Modified Davis grading, camera: NIDEK AFC-230 — 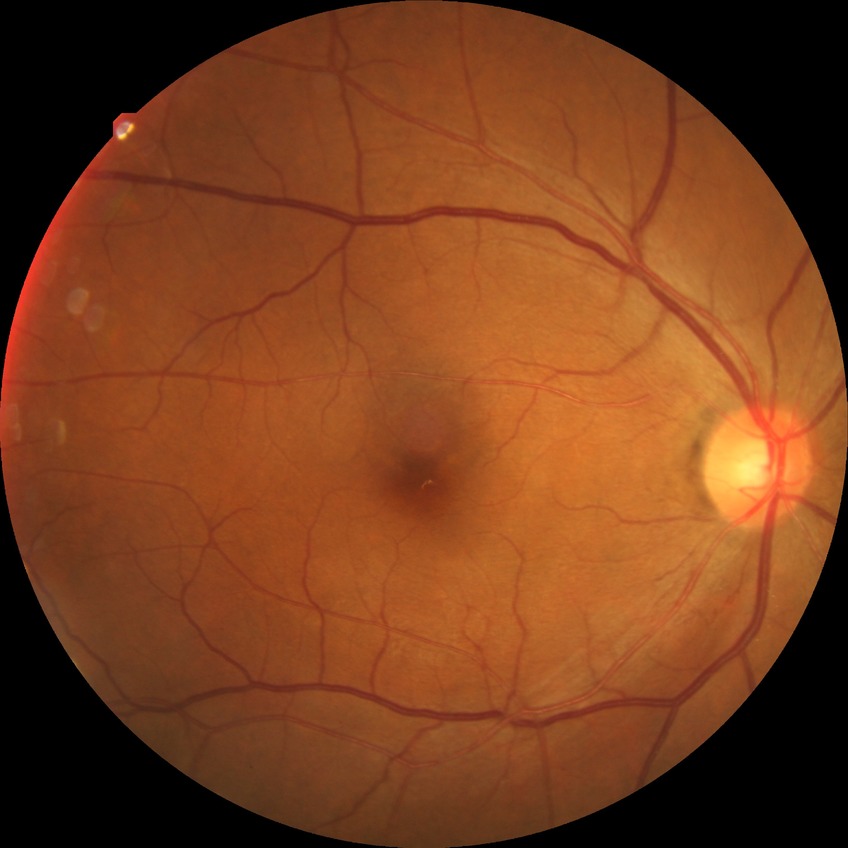

Diabetic retinopathy (DR): no diabetic retinopathy (NDR).